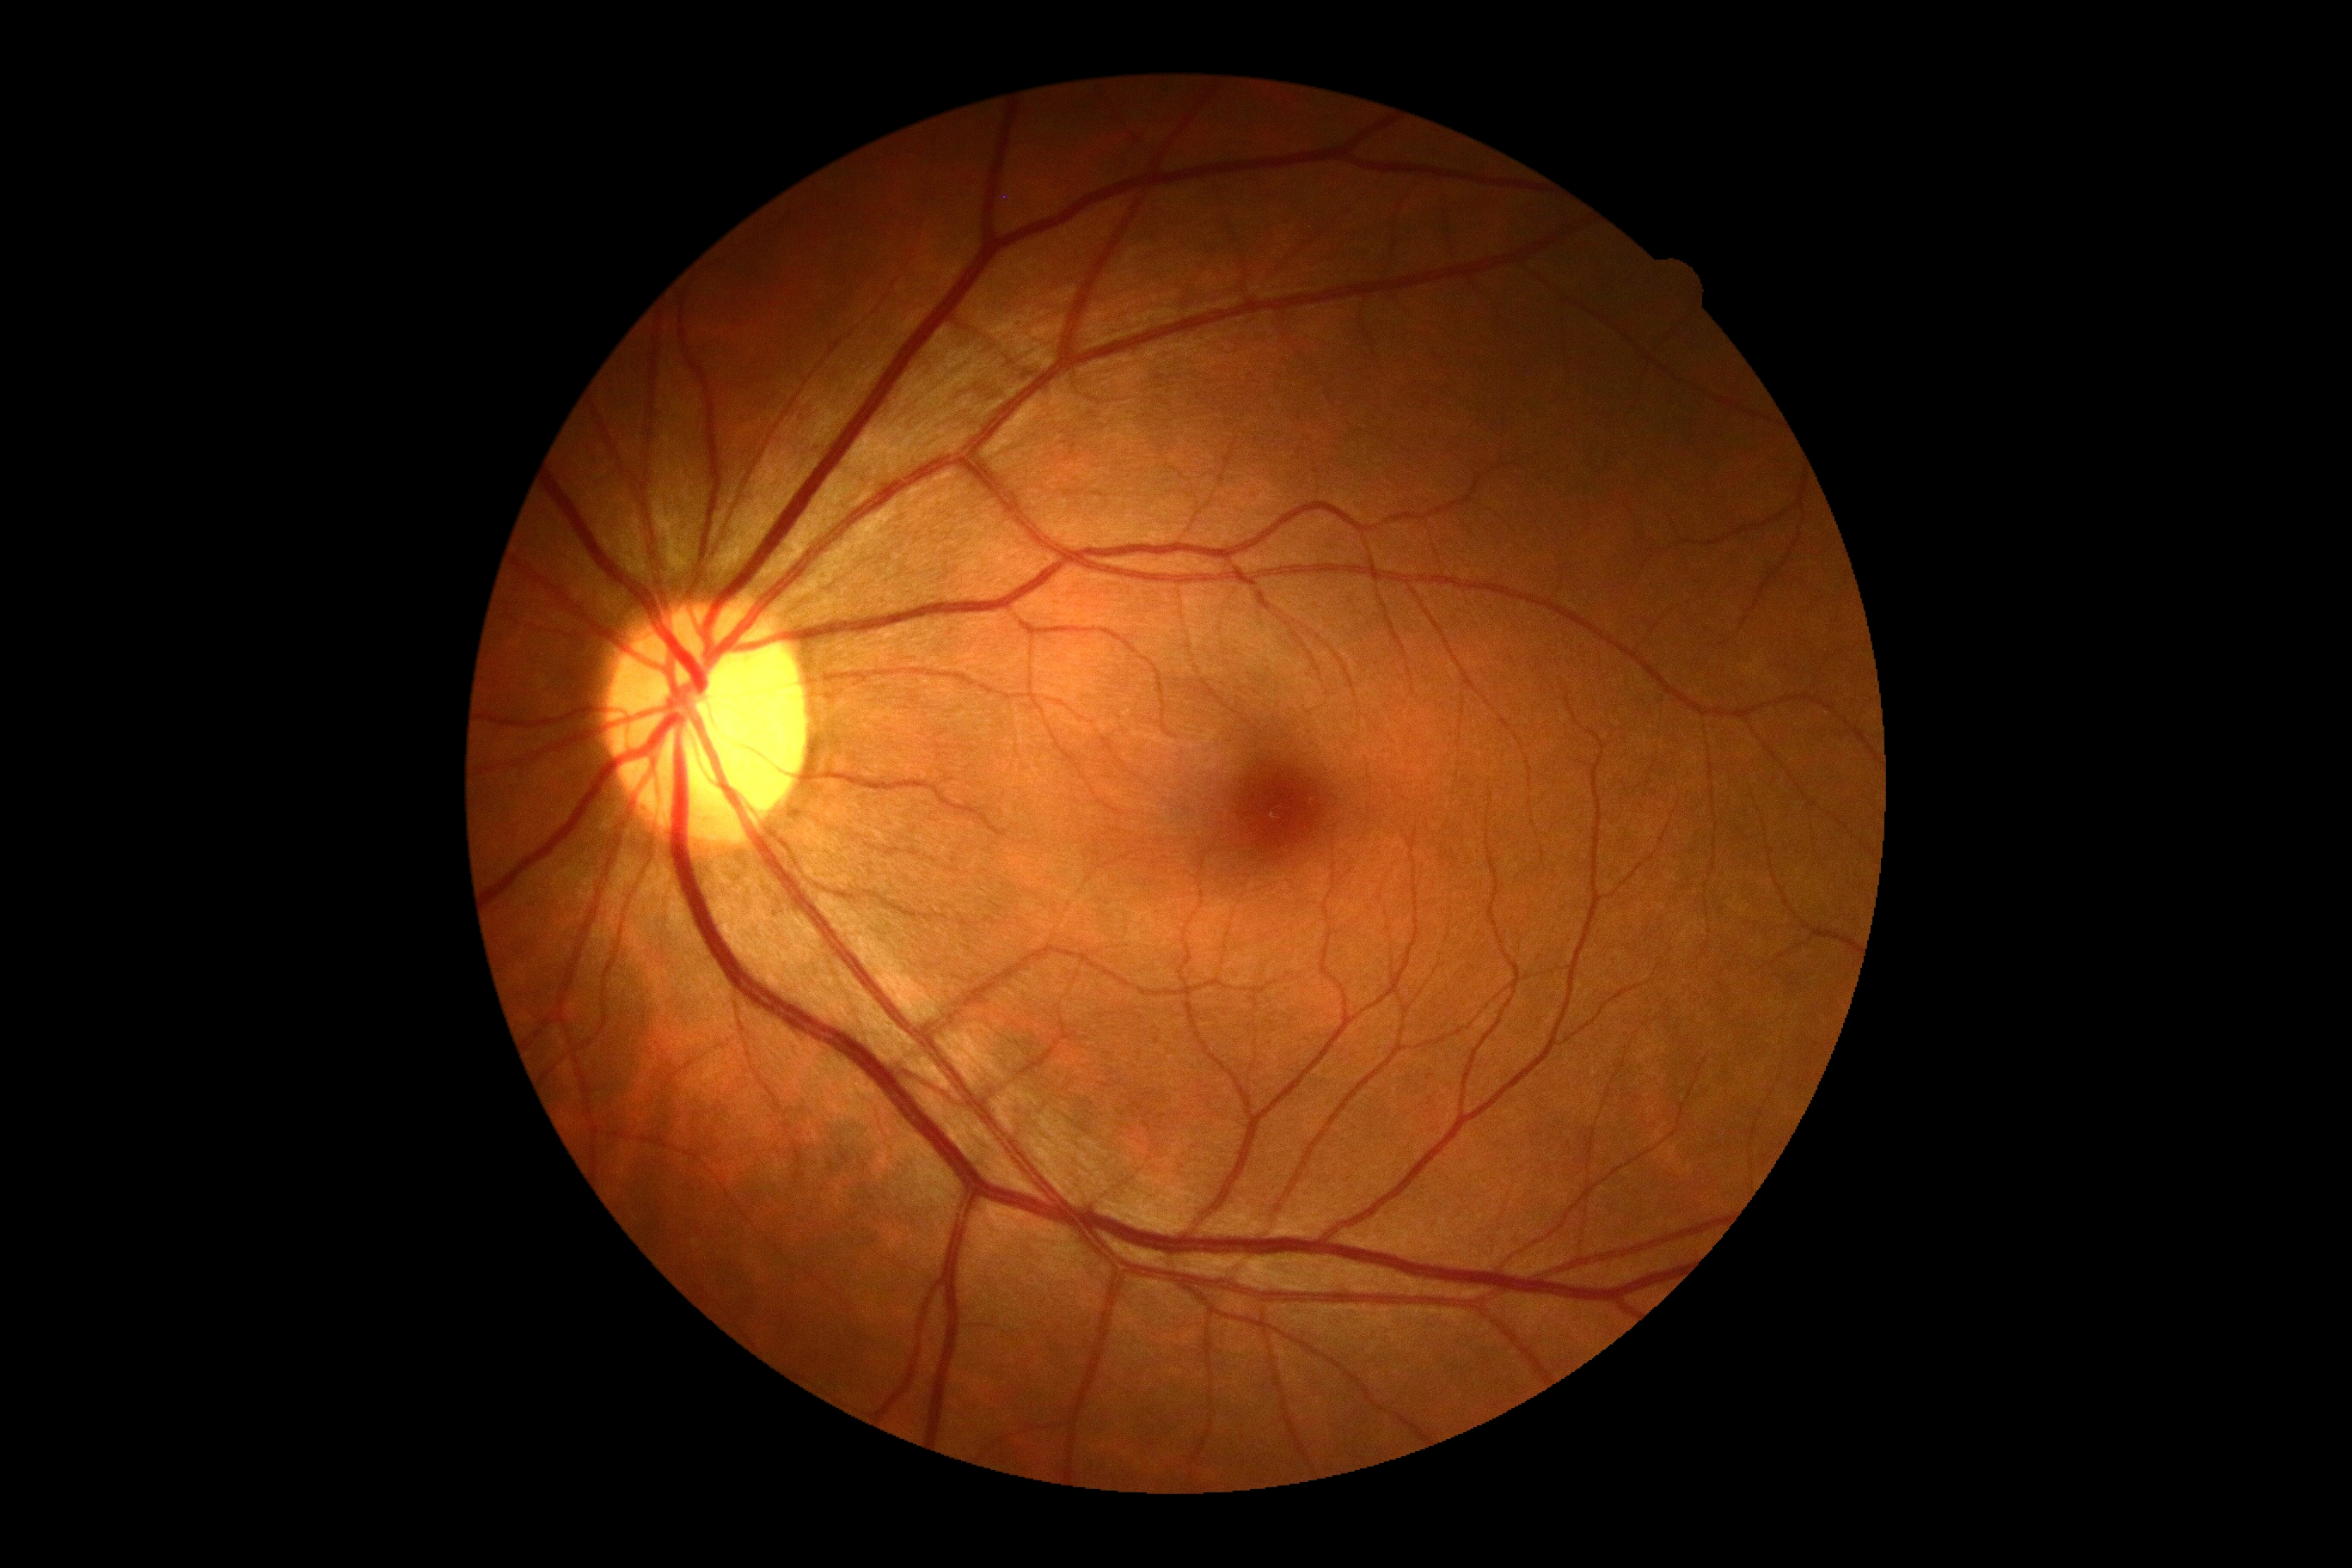 – retinopathy — grade 0